2352 x 1568 pixels, fundus photo
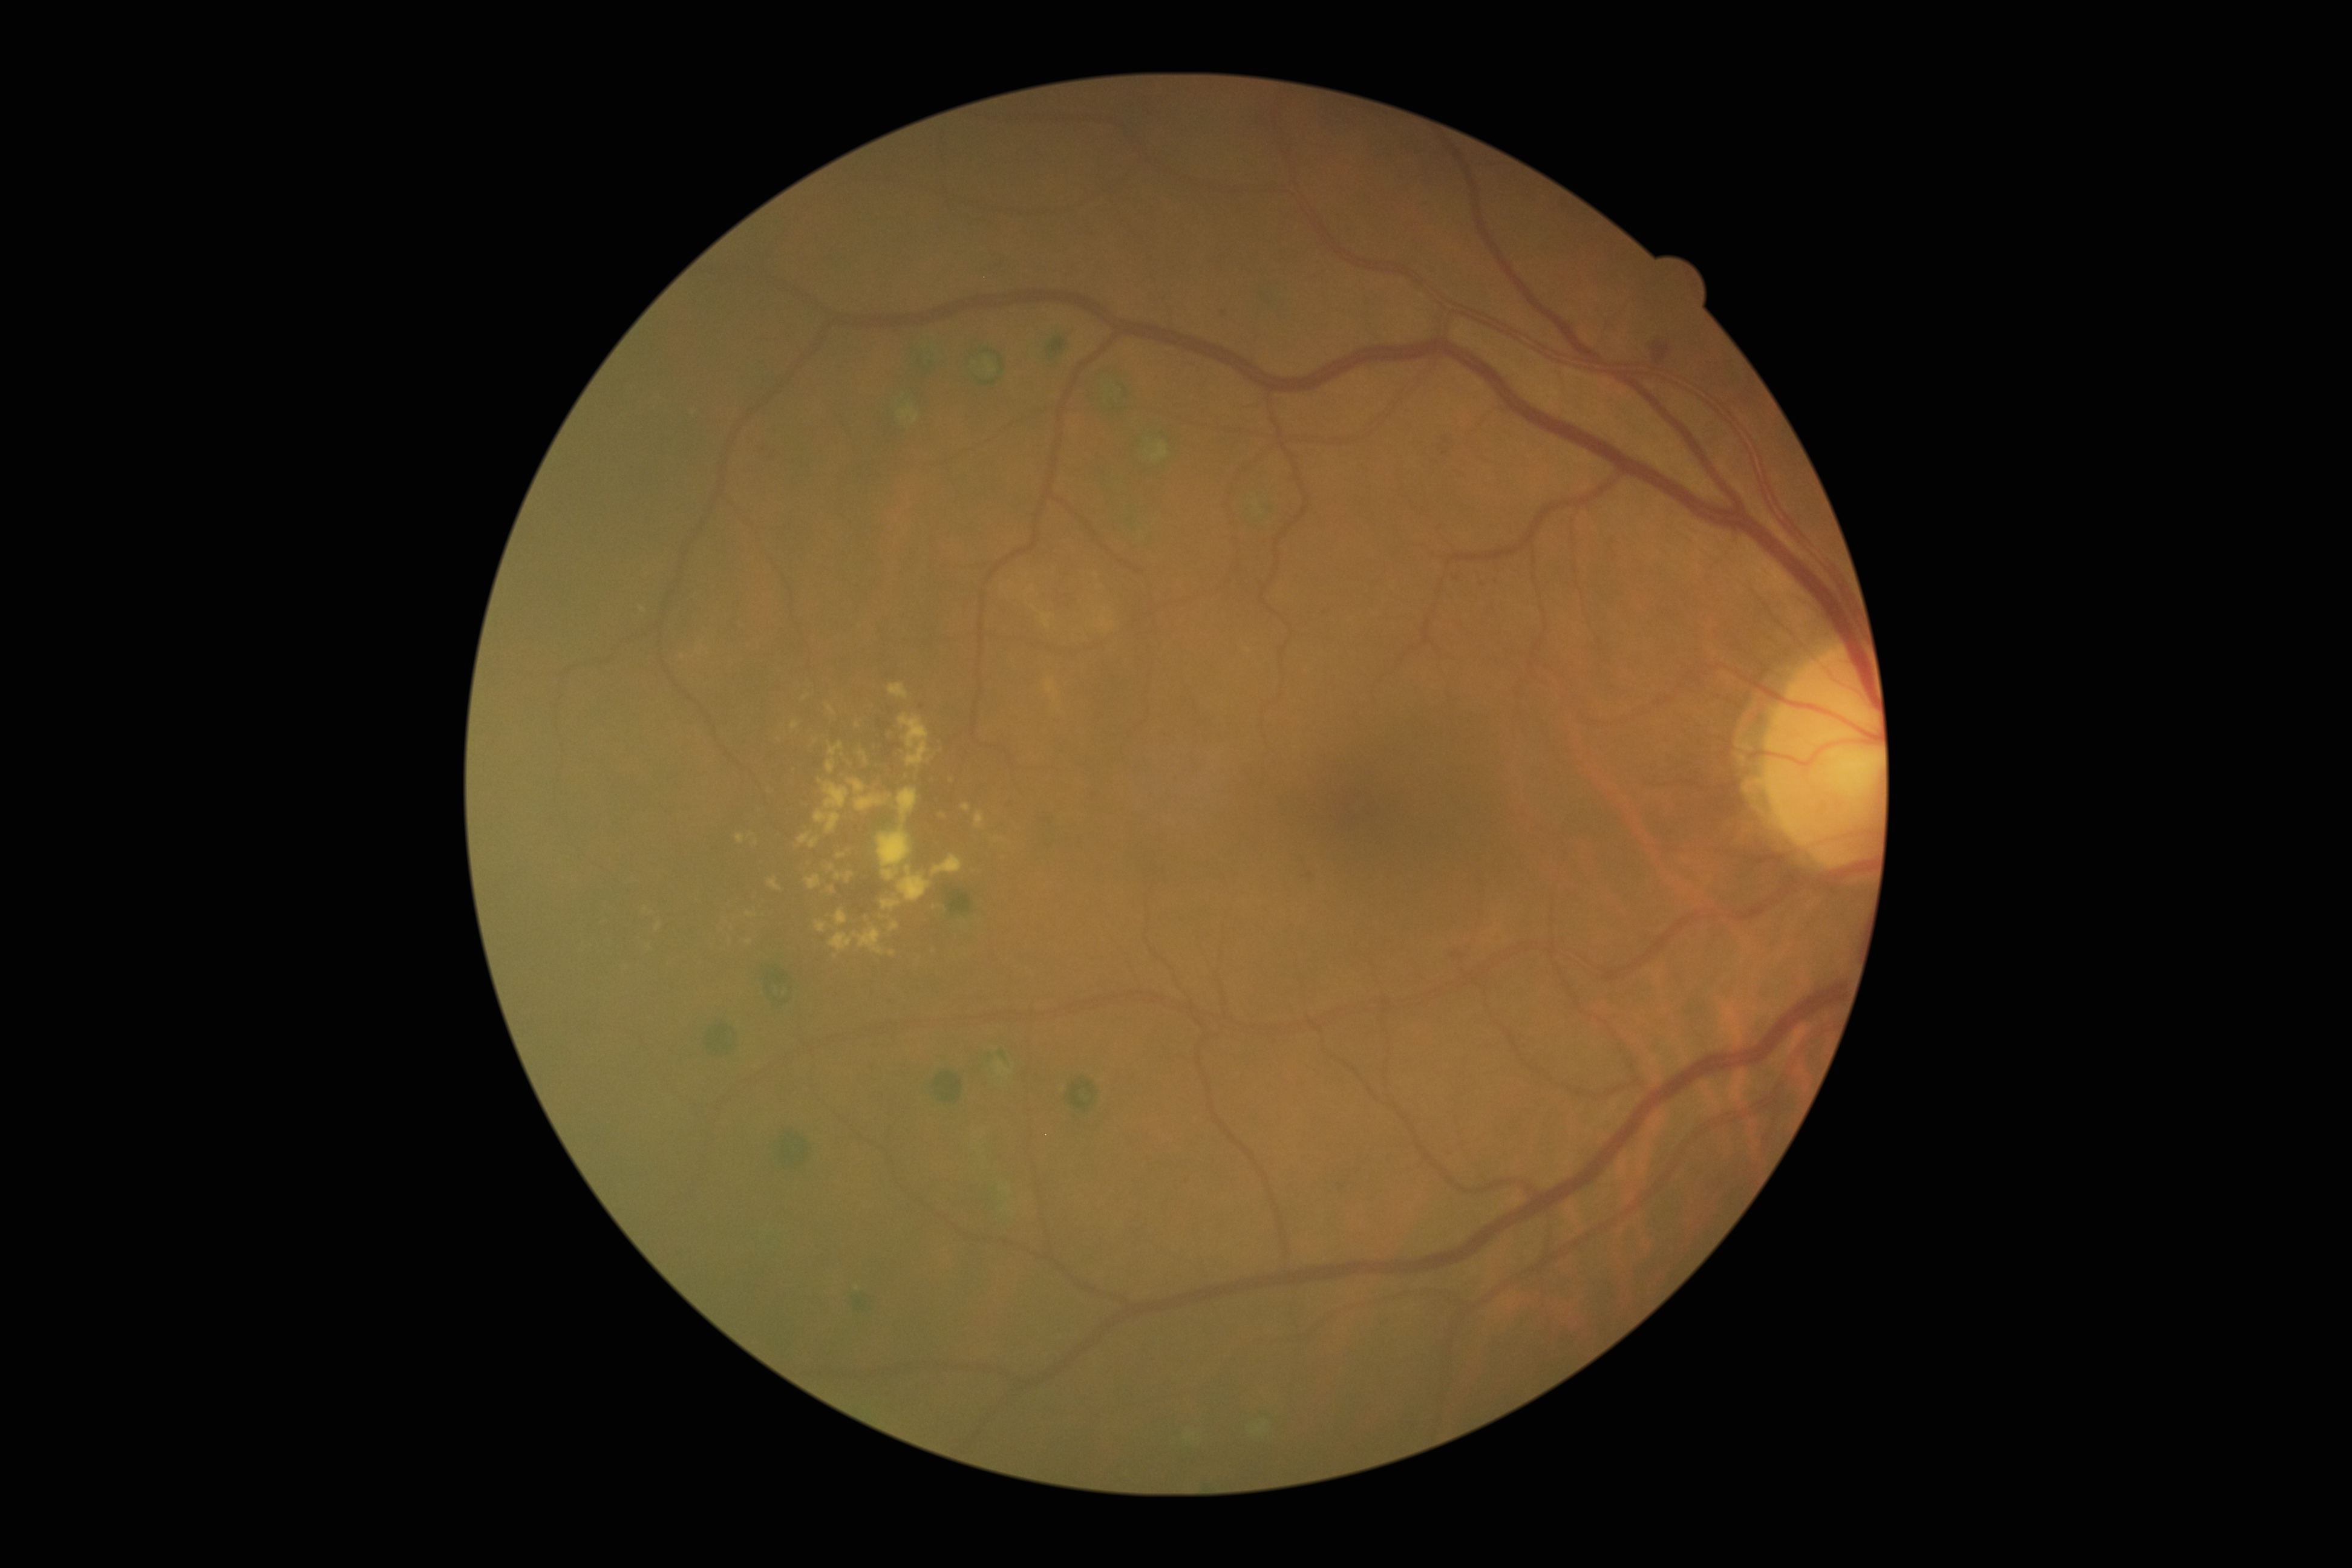

<lesions partial="true">
  <dr_grade>2</dr_grade>
  <ex partial="true">box(827, 760, 837, 774), box(828, 885, 835, 893), box(799, 833, 820, 848), box(975, 811, 985, 828), box(736, 834, 745, 844), box(897, 866, 931, 902), box(891, 923, 900, 931), box(856, 794, 884, 811), box(849, 780, 866, 793), box(823, 782, 849, 809)</ex>
  <ex_small>pt(892, 953), pt(858, 725), pt(820, 781), pt(642, 609)</ex_small>
</lesions>